Camera: Phoenix ICON (100° FOV); infant wide-field fundus photograph:
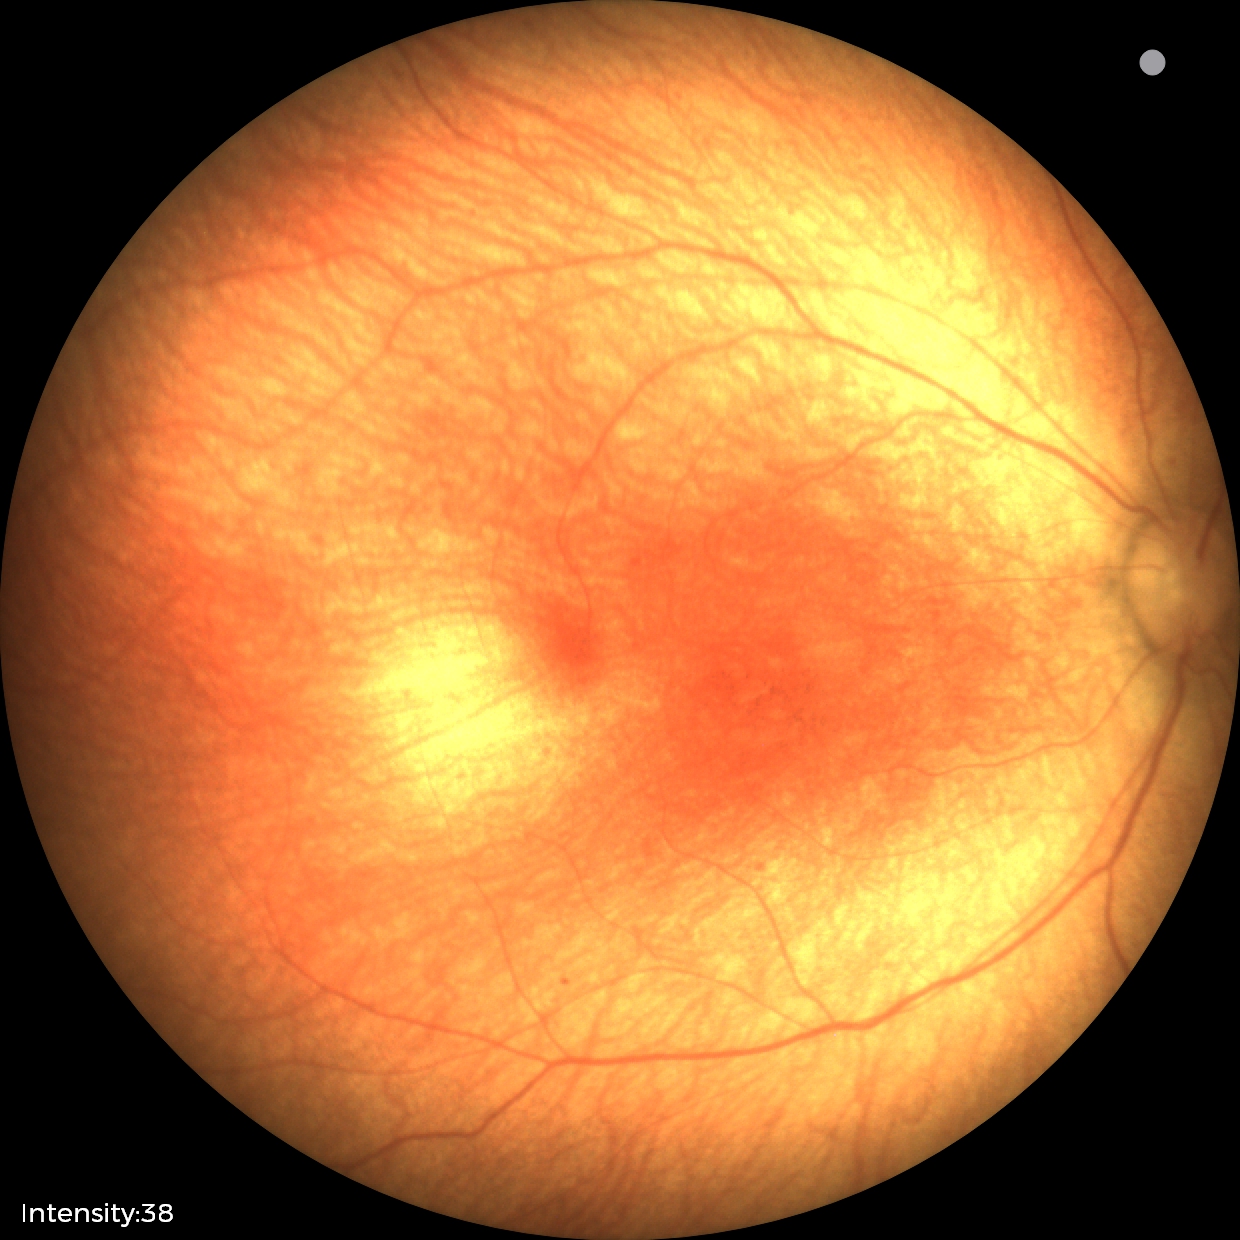 Assessment: normal fundus examination.